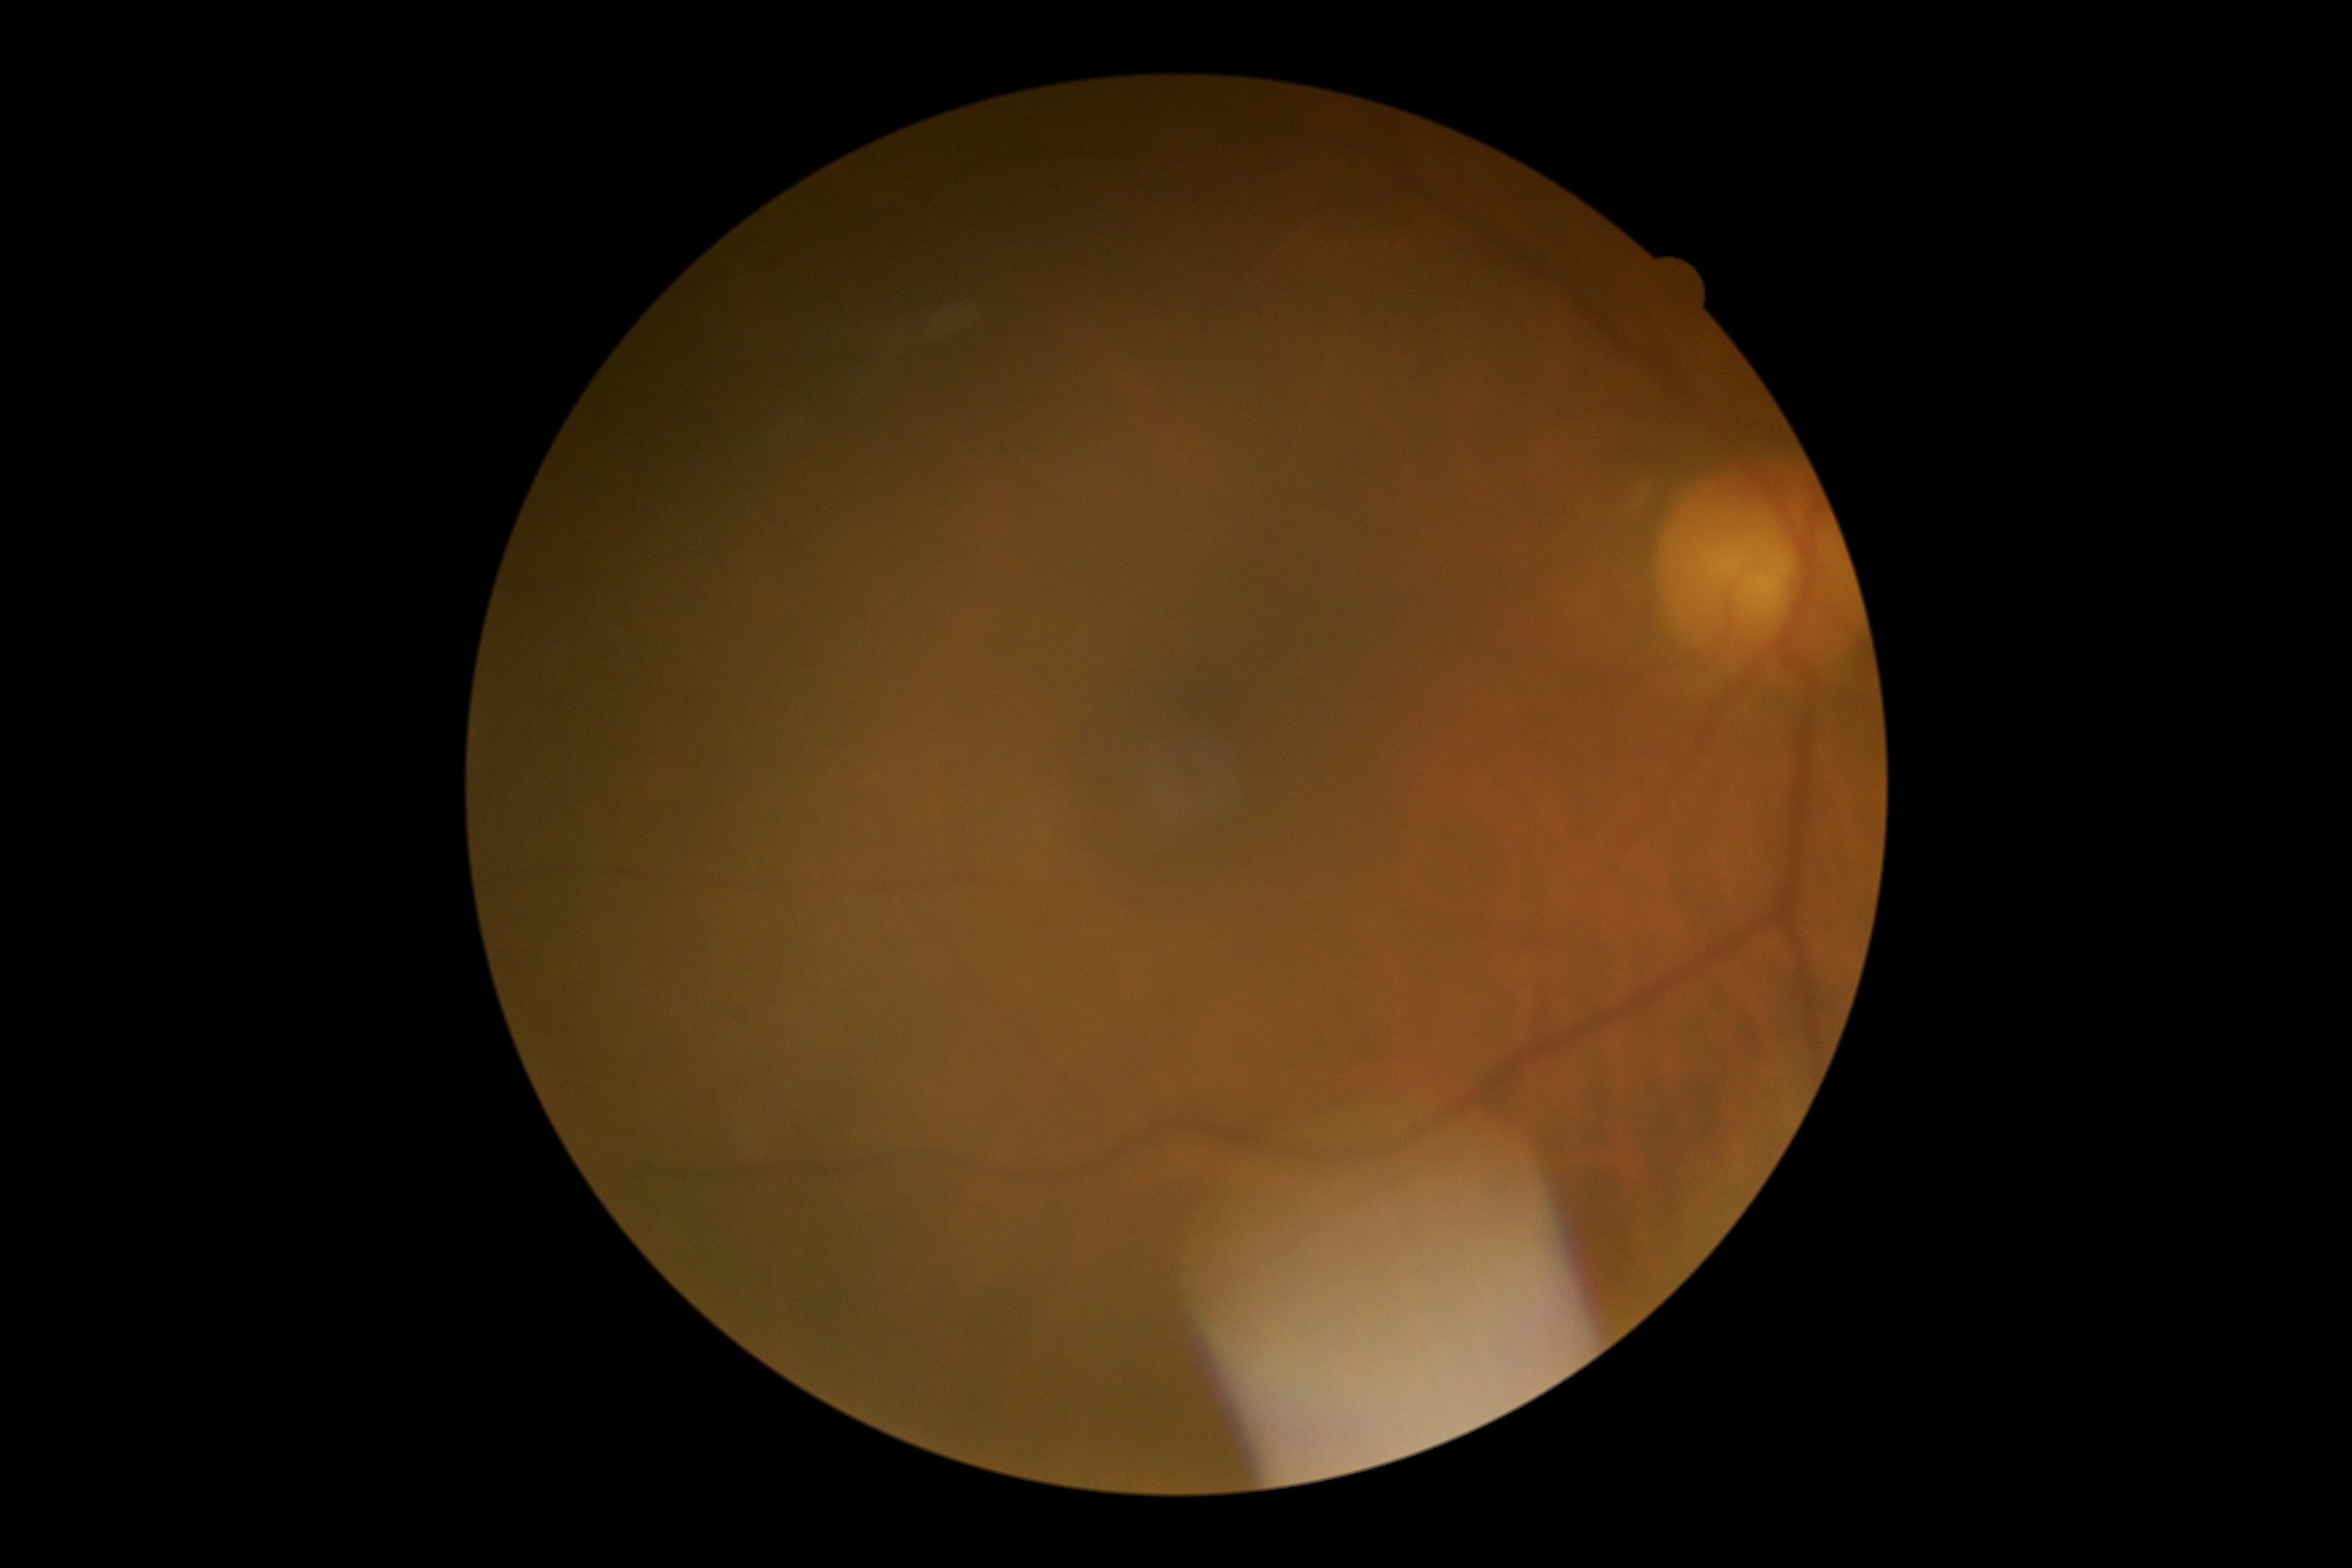

DR is no apparent retinopathy (grade 0).